Pediatric retinal photograph (wide-field); captured with the Clarity RetCam 3 (130° field of view); 640x480px:
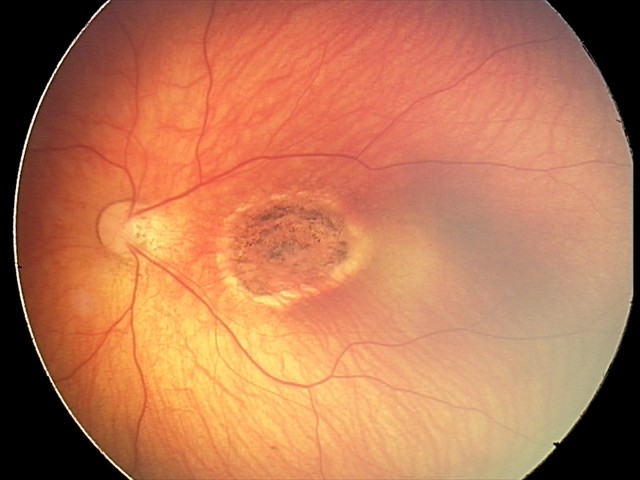

Finding = toxoplasmosis chorioretinitis.